DR severity per modified Davis staging — 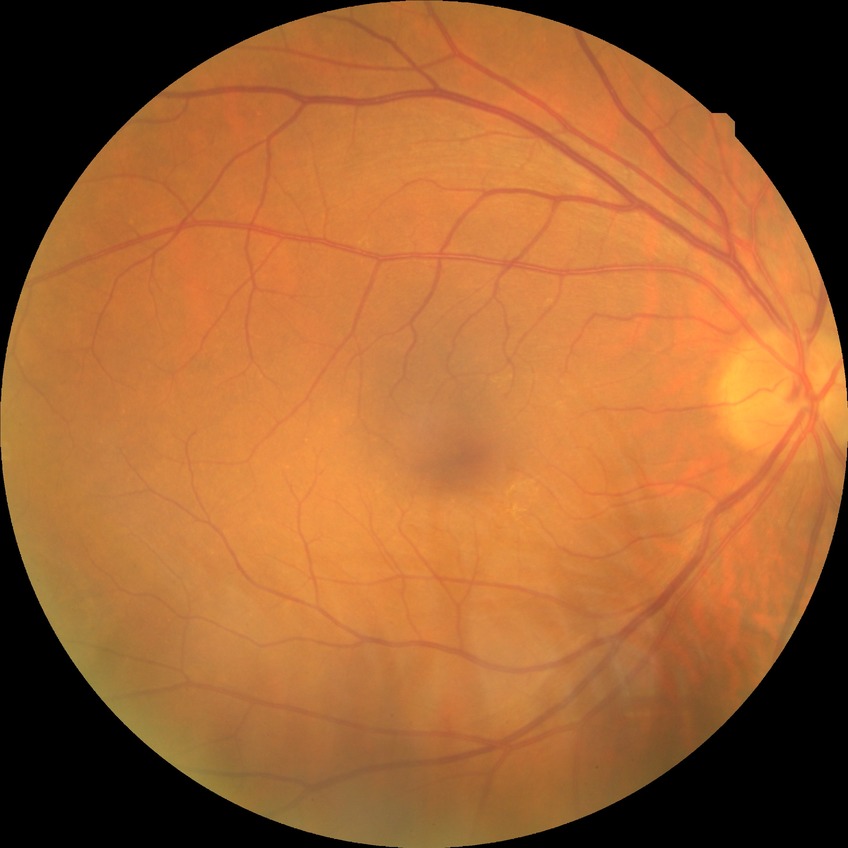
Davis grade is NDR.